Wide-field contact fundus photograph of an infant:
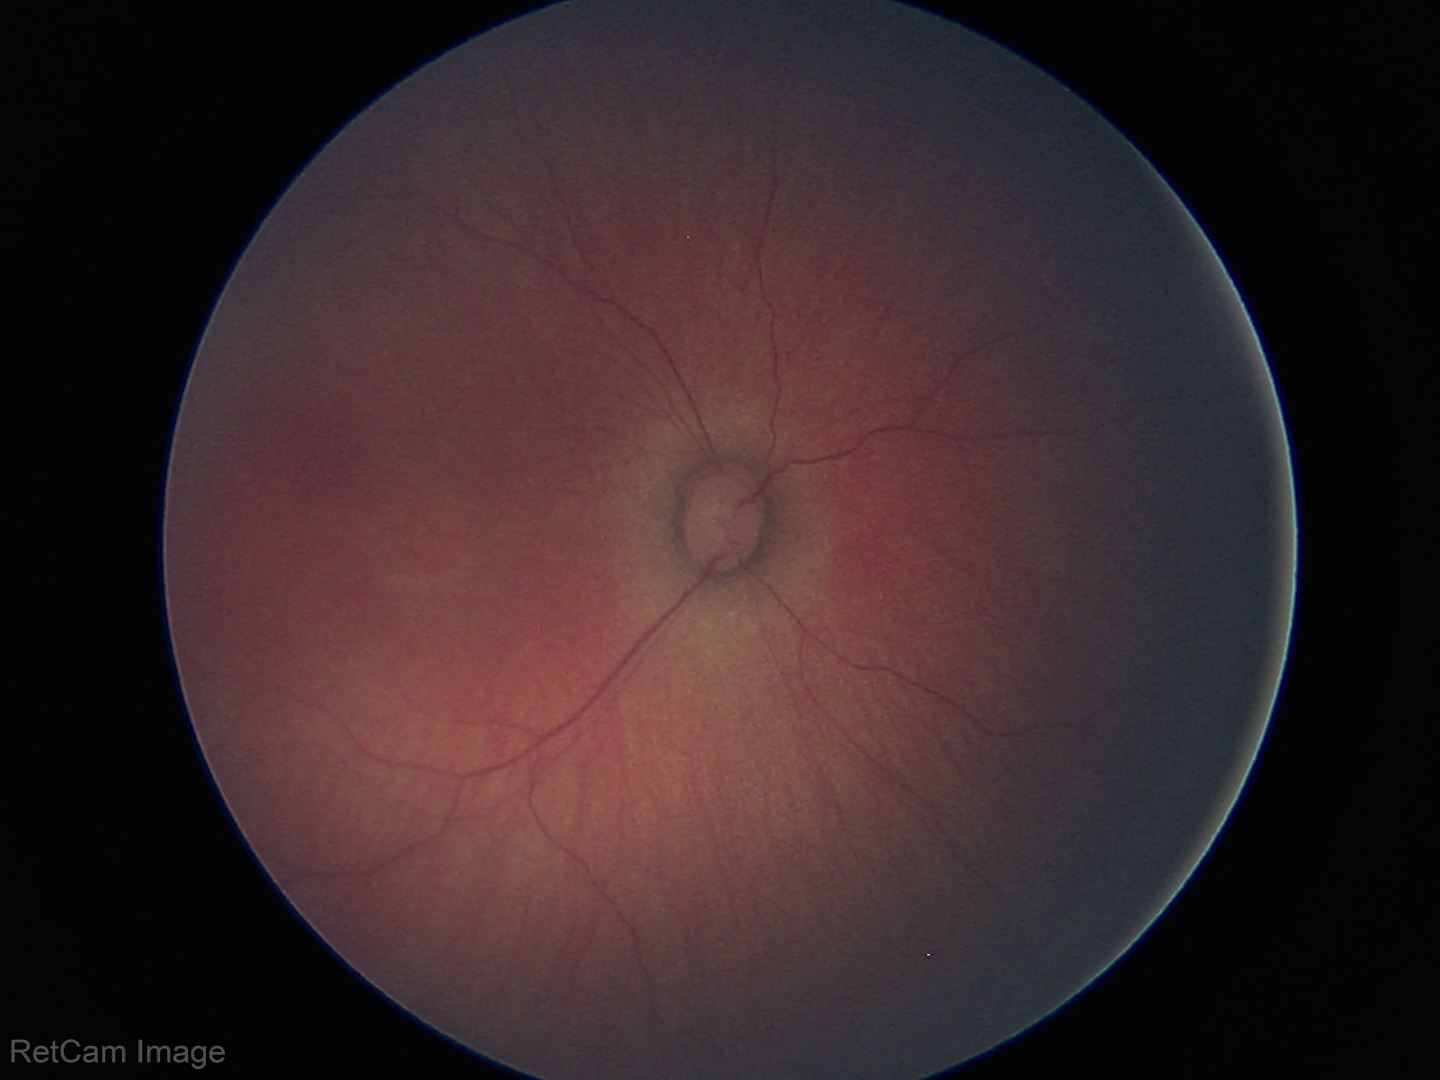

Screening examination diagnosed as physiological.